Wide-field fundus photograph from neonatal ROP screening.
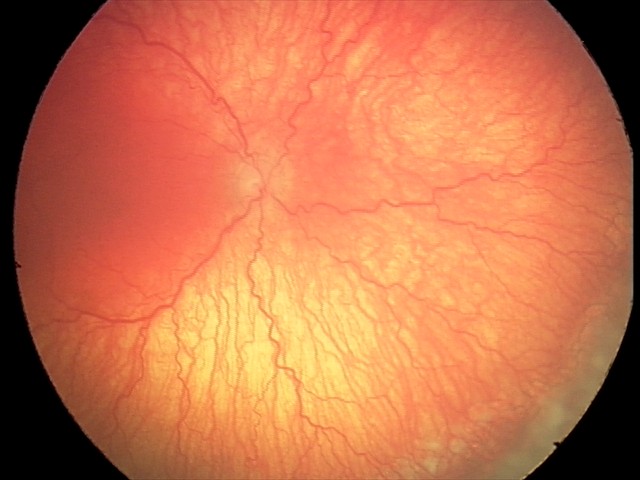 Plus disease = present | finding = A-ROP (aggressive ROP).